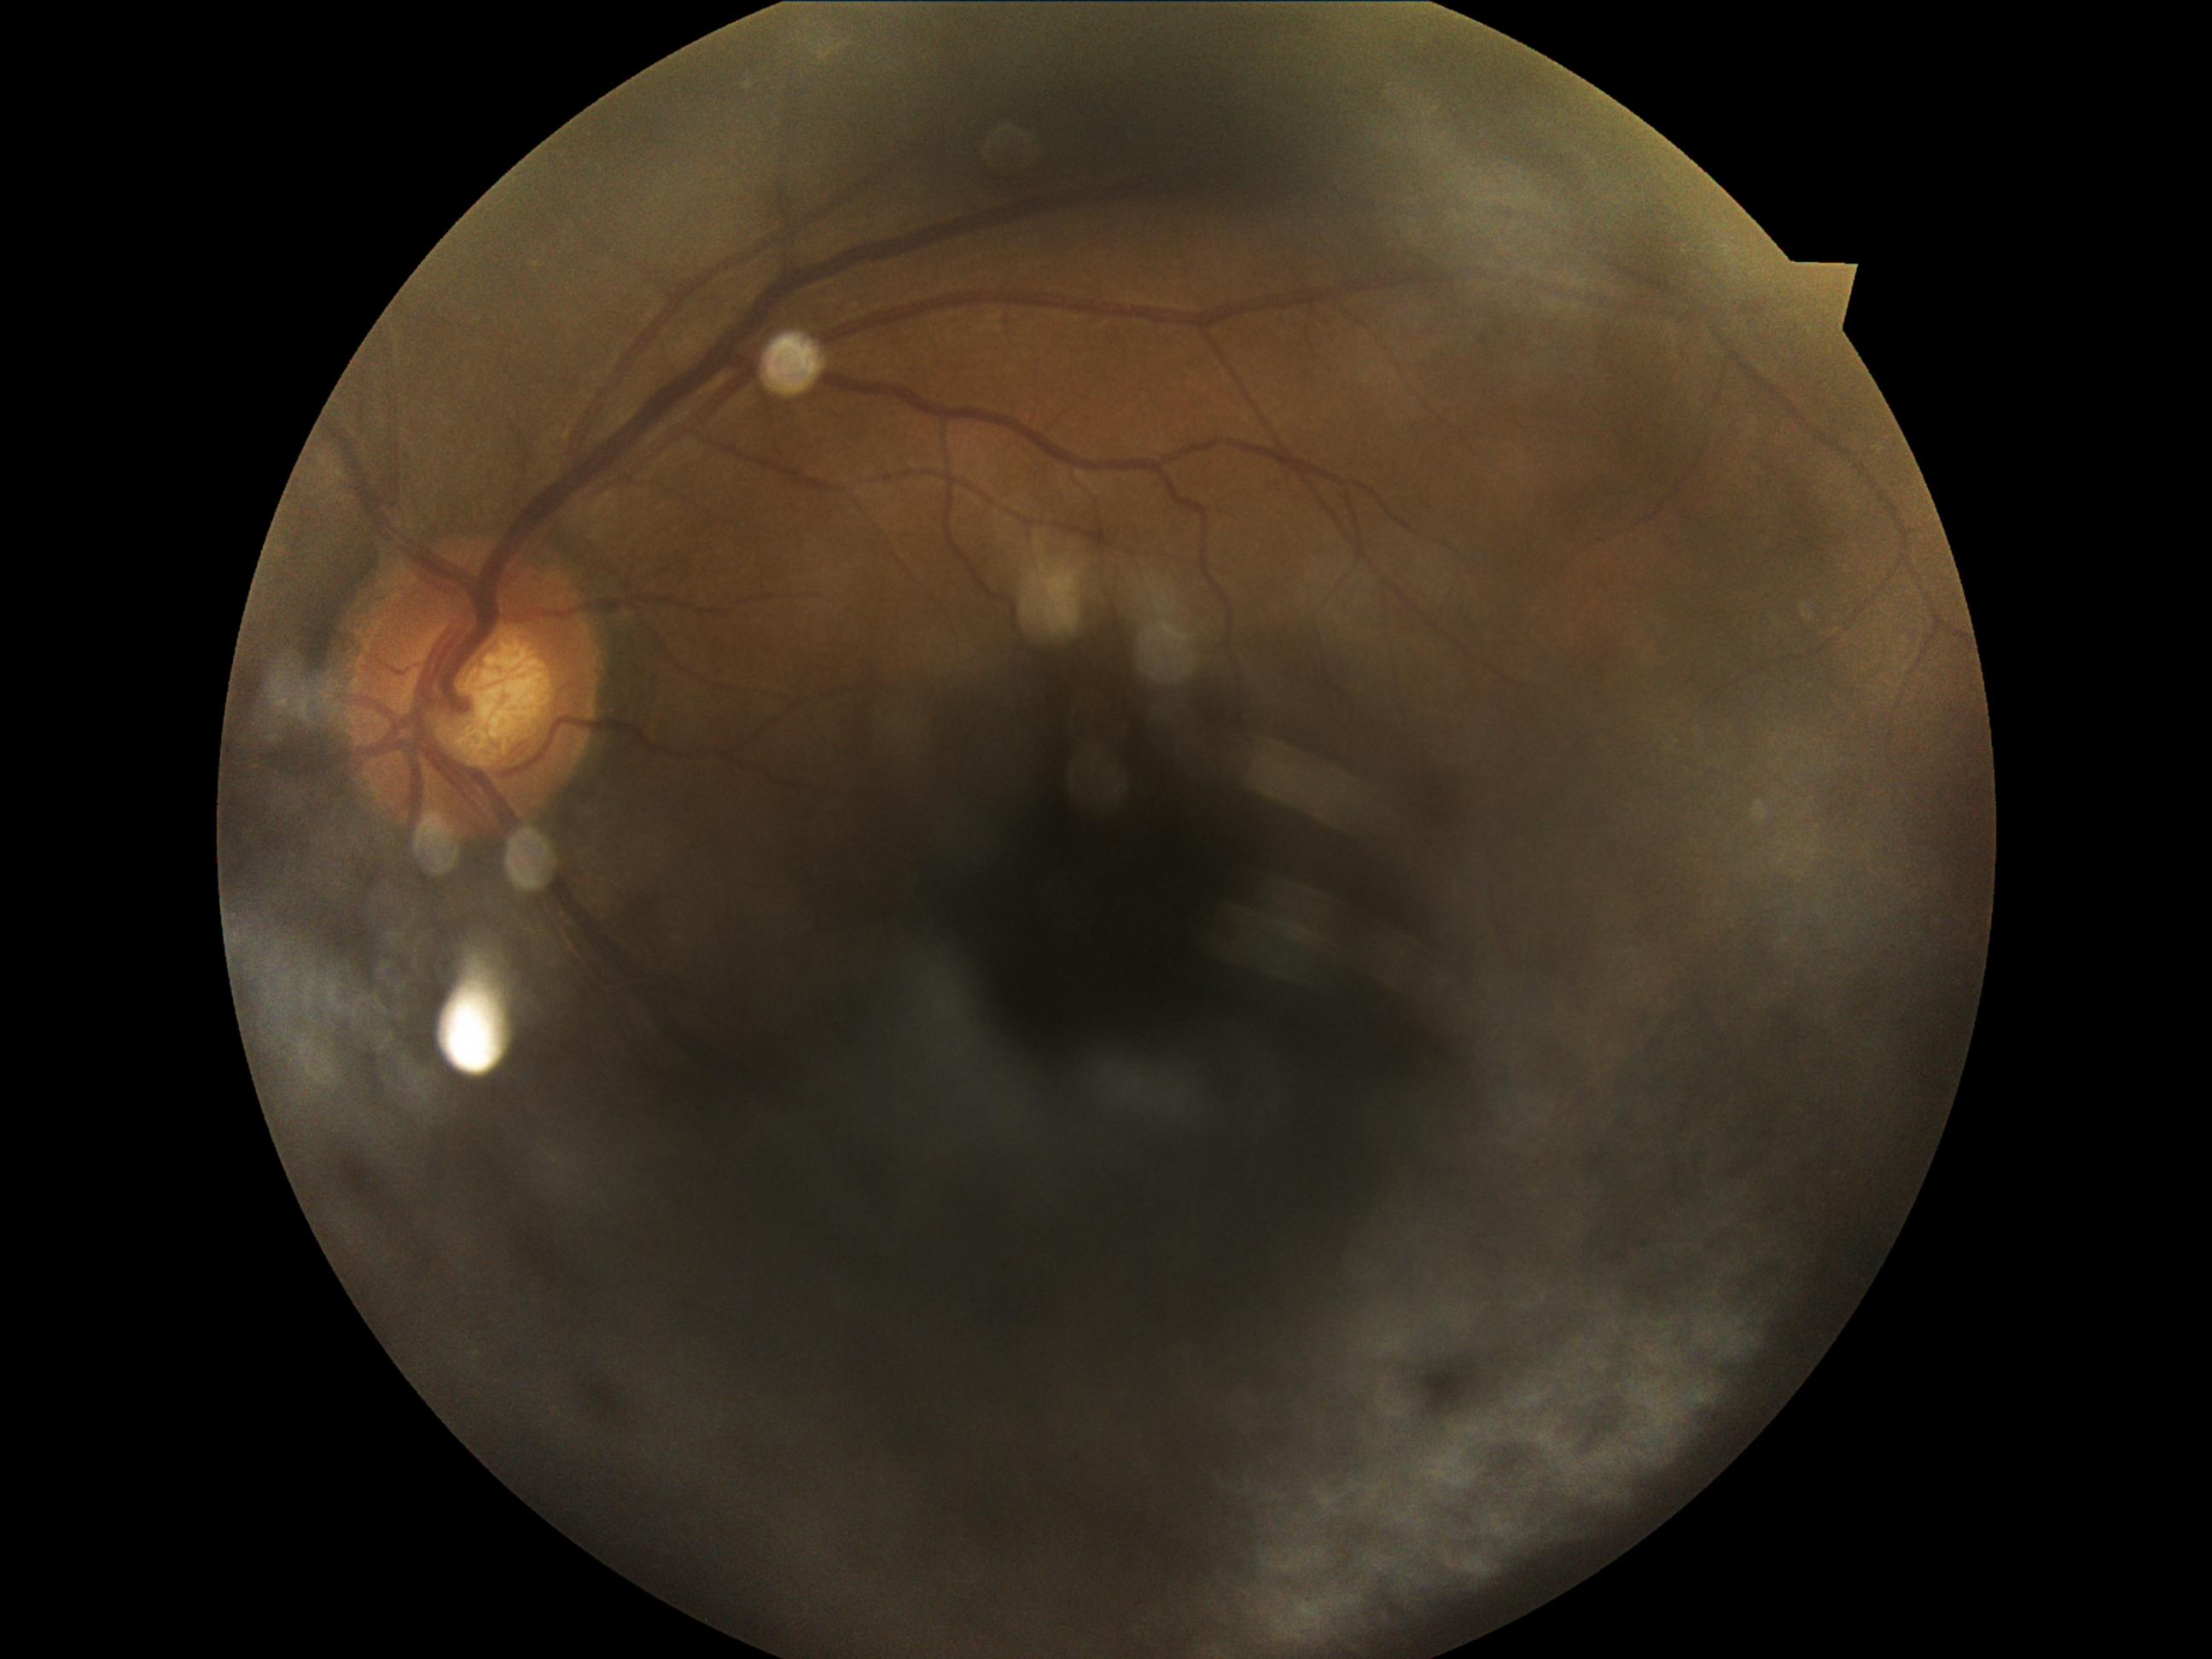
Diabetic retinopathy (DR) is ungradable due to poor image quality.